No pharmacologic dilation; modified Davis classification; 848x848px: 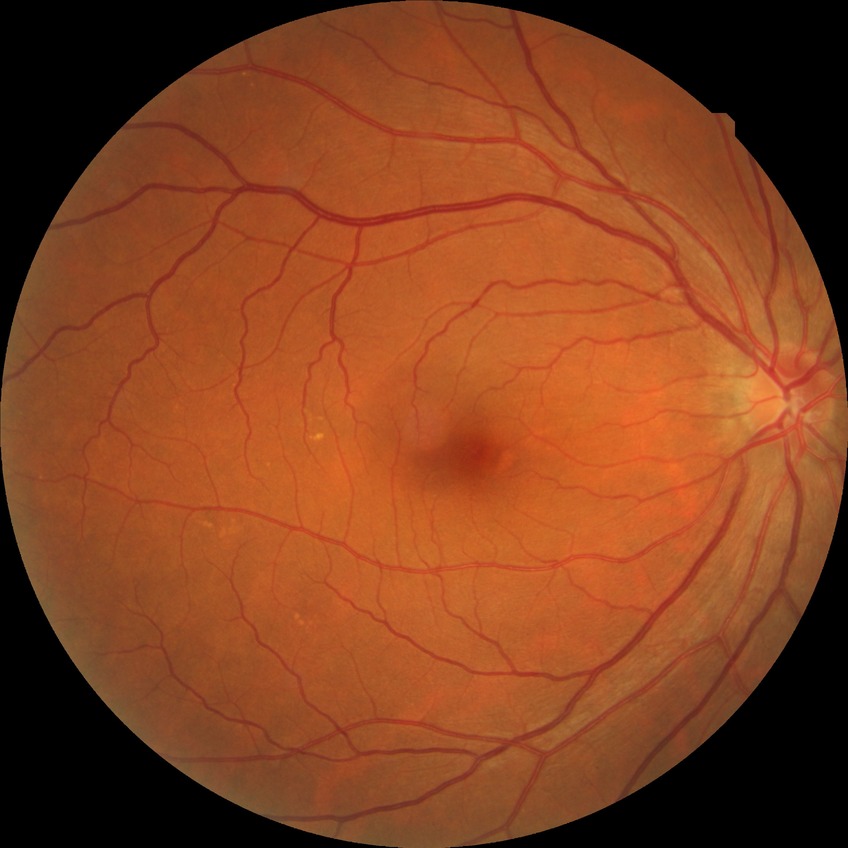

Diabetic retinopathy (DR): no diabetic retinopathy (NDR).